Image size 2212x1661; corneal thickness: 531 µm; optic disc-centered; FOV: 30 degrees; acquired with a Topcon TRC-NW400; CFP; sex: F: 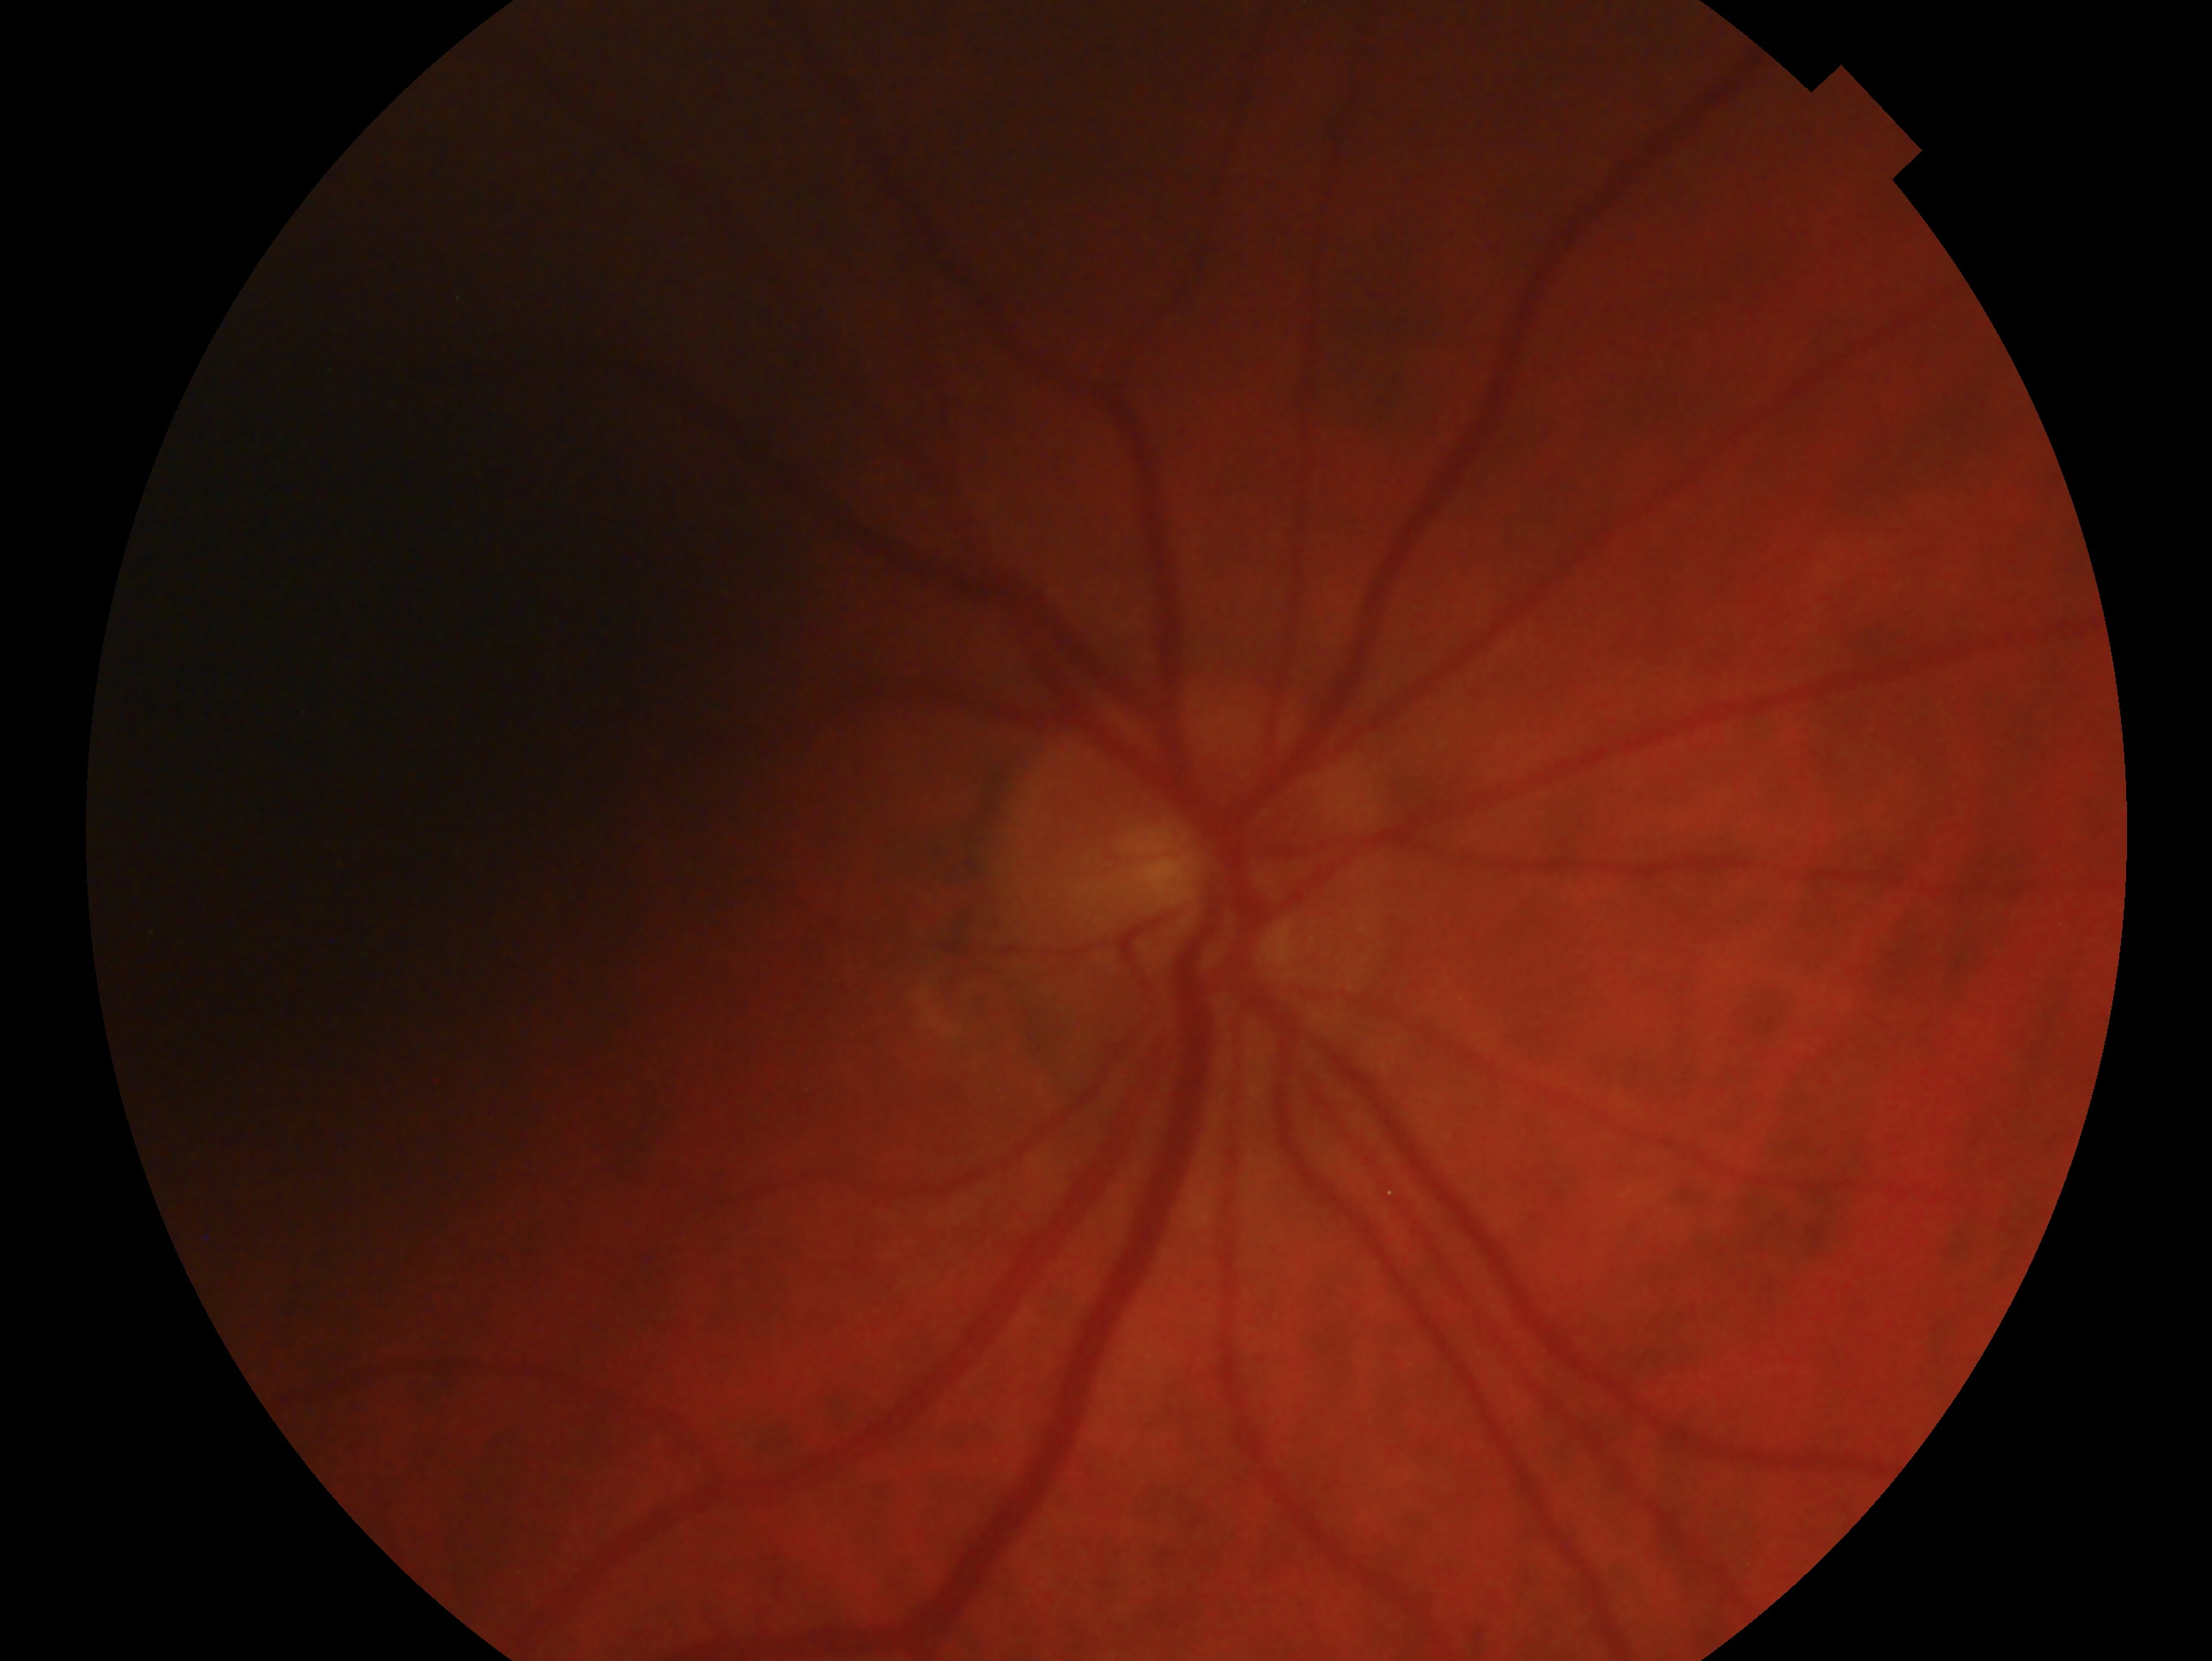
Imaged eye: right eye.
Glaucoma status: negative for glaucoma.